Davis DR grading; without pupil dilation:
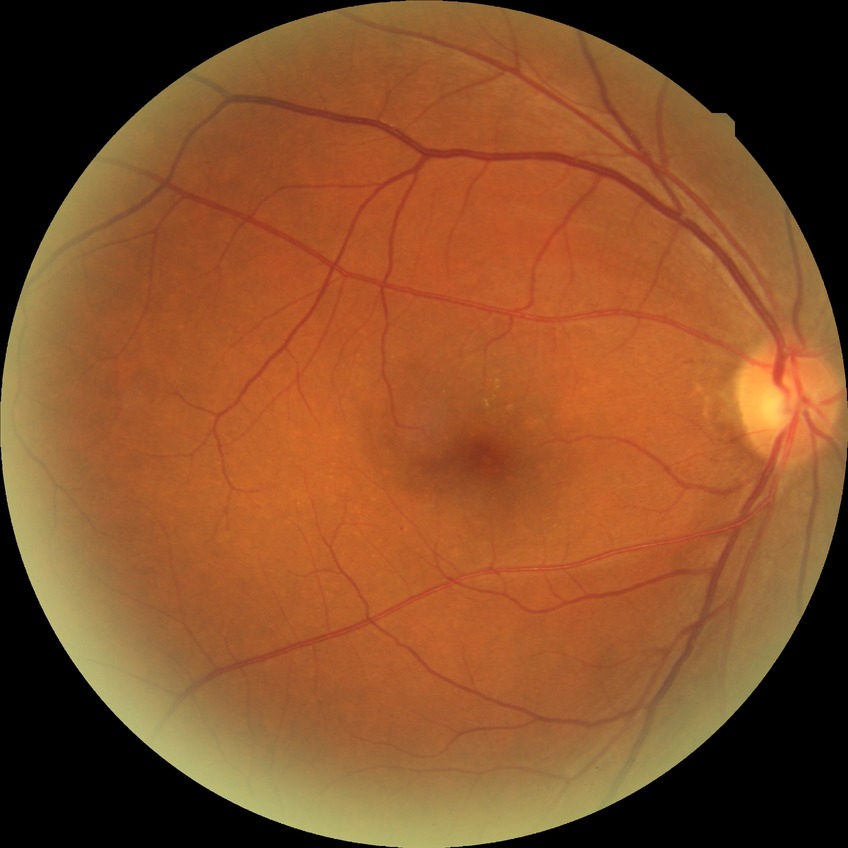
DR class: non-proliferative diabetic retinopathy.
Diabetic retinopathy (DR) is simple diabetic retinopathy (SDR).